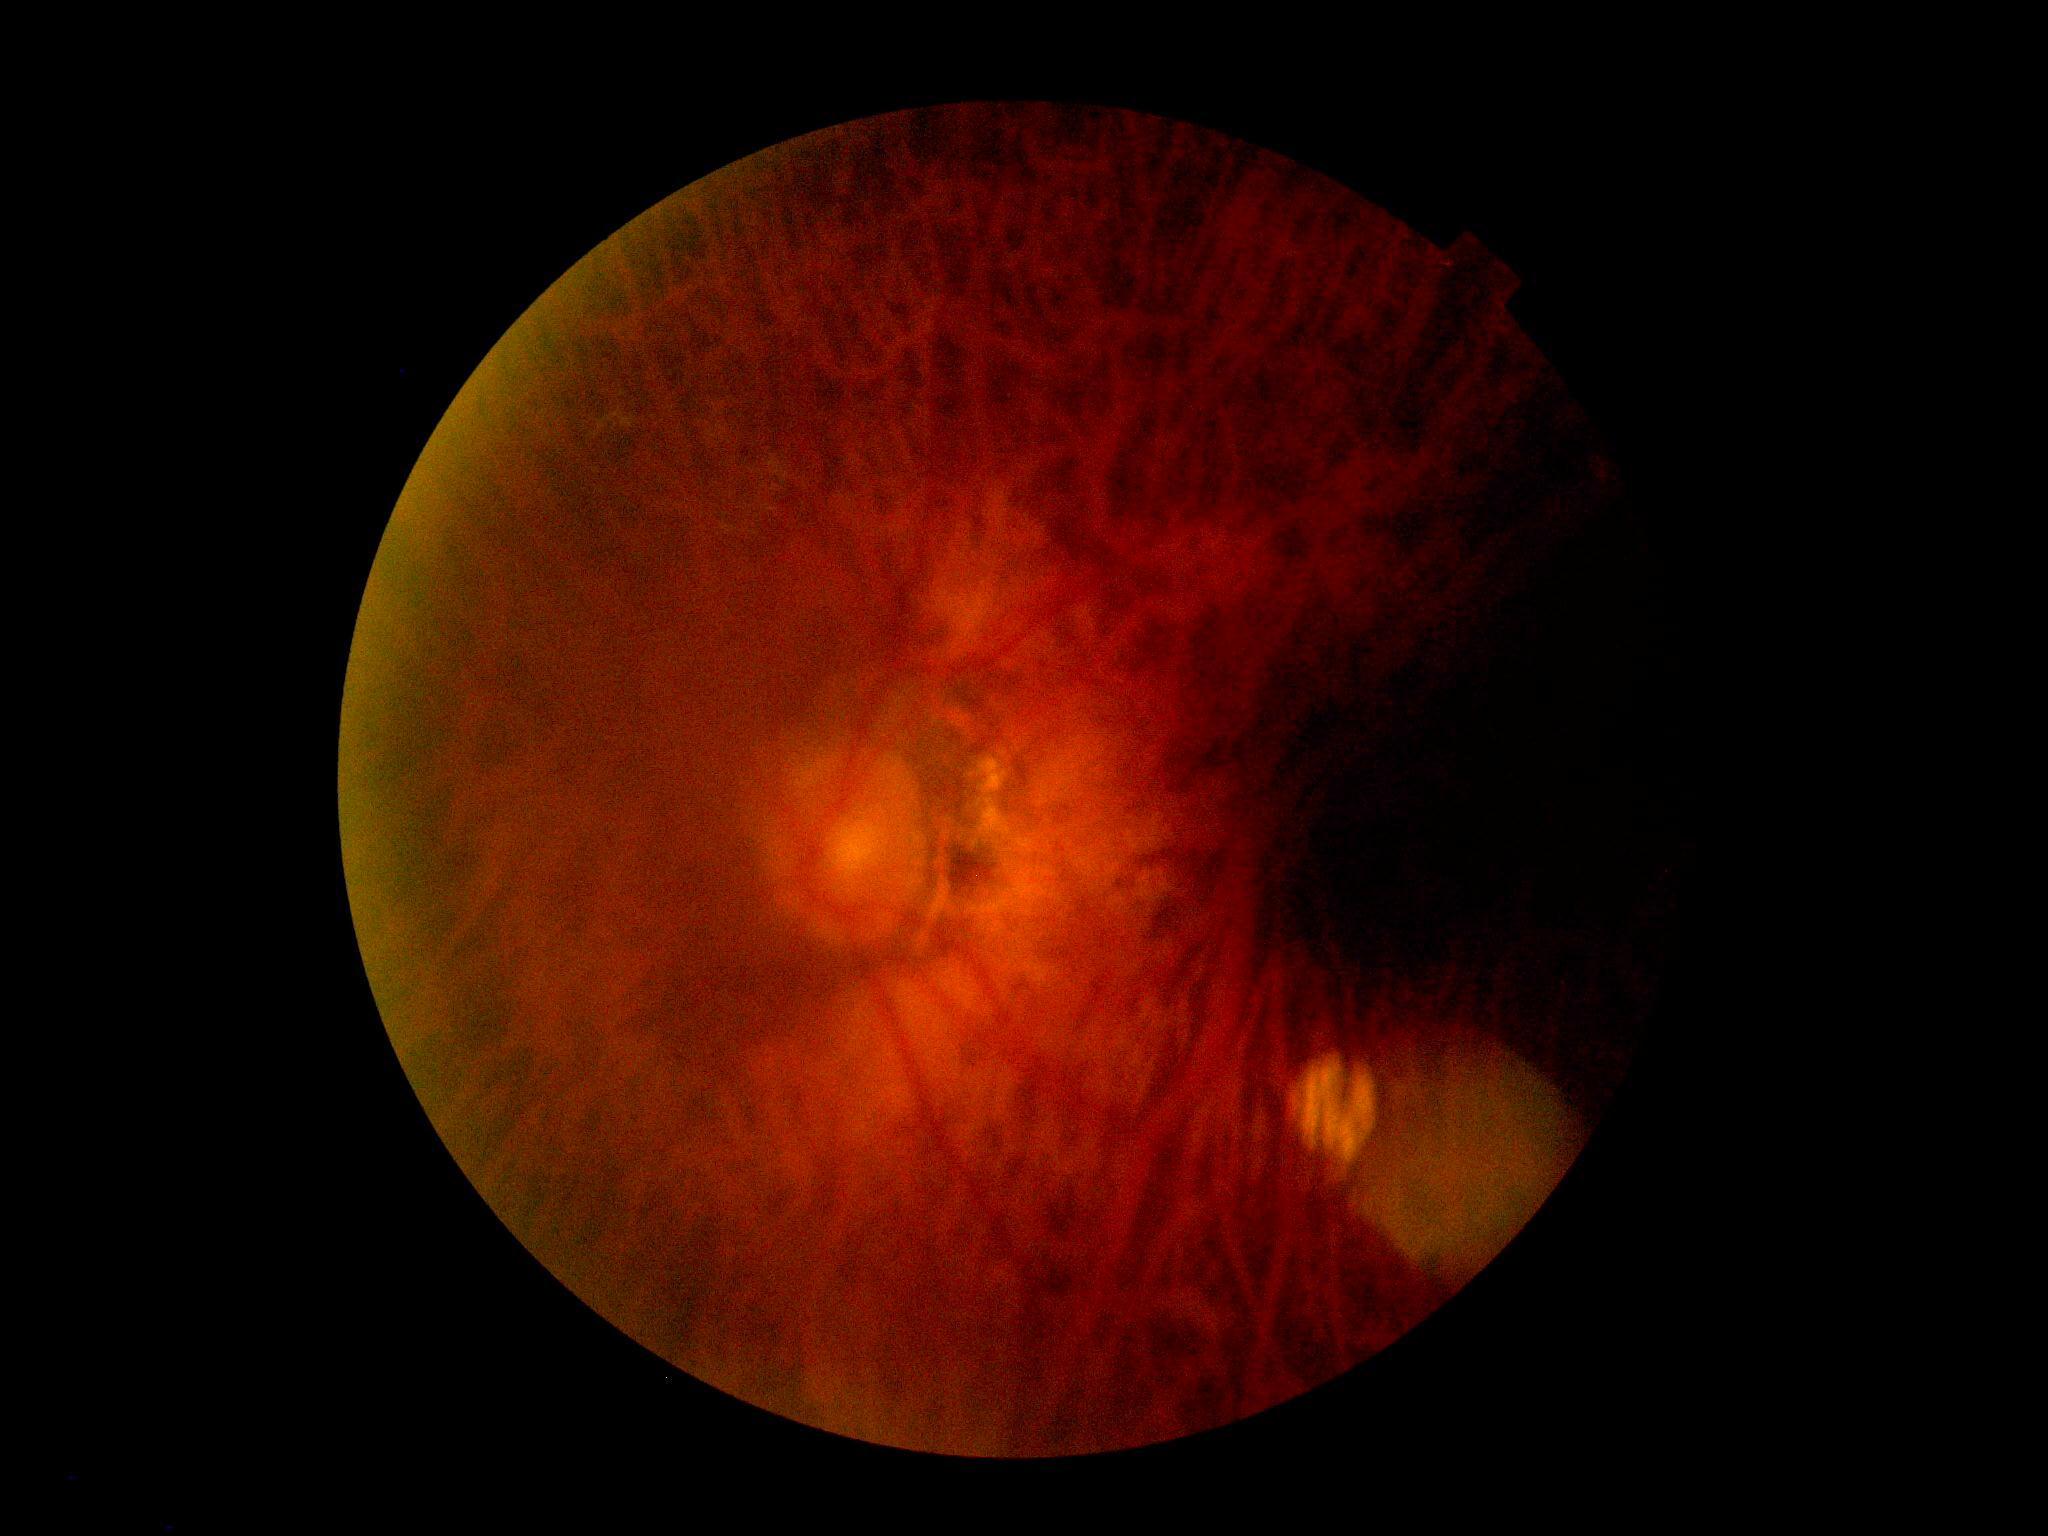
The image cannot be graded for diabetic retinopathy.
Diabetic retinopathy severity is ungradable.